Wide-field fundus photograph from neonatal ROP screening · 130° field of view (Clarity RetCam 3):
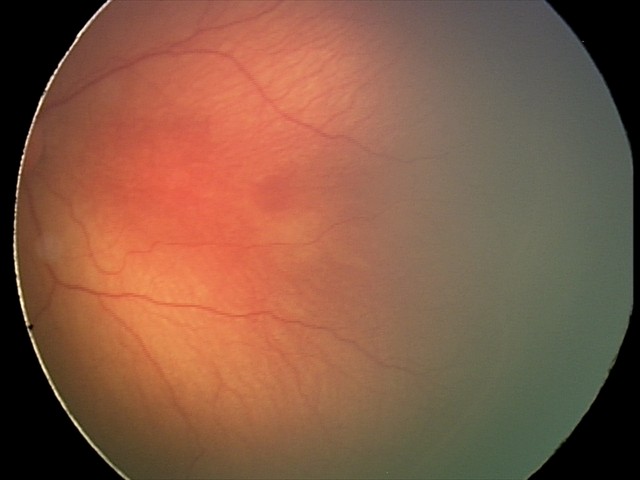 Q: What is the diagnosis from this examination?
A: ROP stage 2